Phoenix ICON, 100° FOV · infant wide-field fundus photograph · 1240 by 1240 pixels.
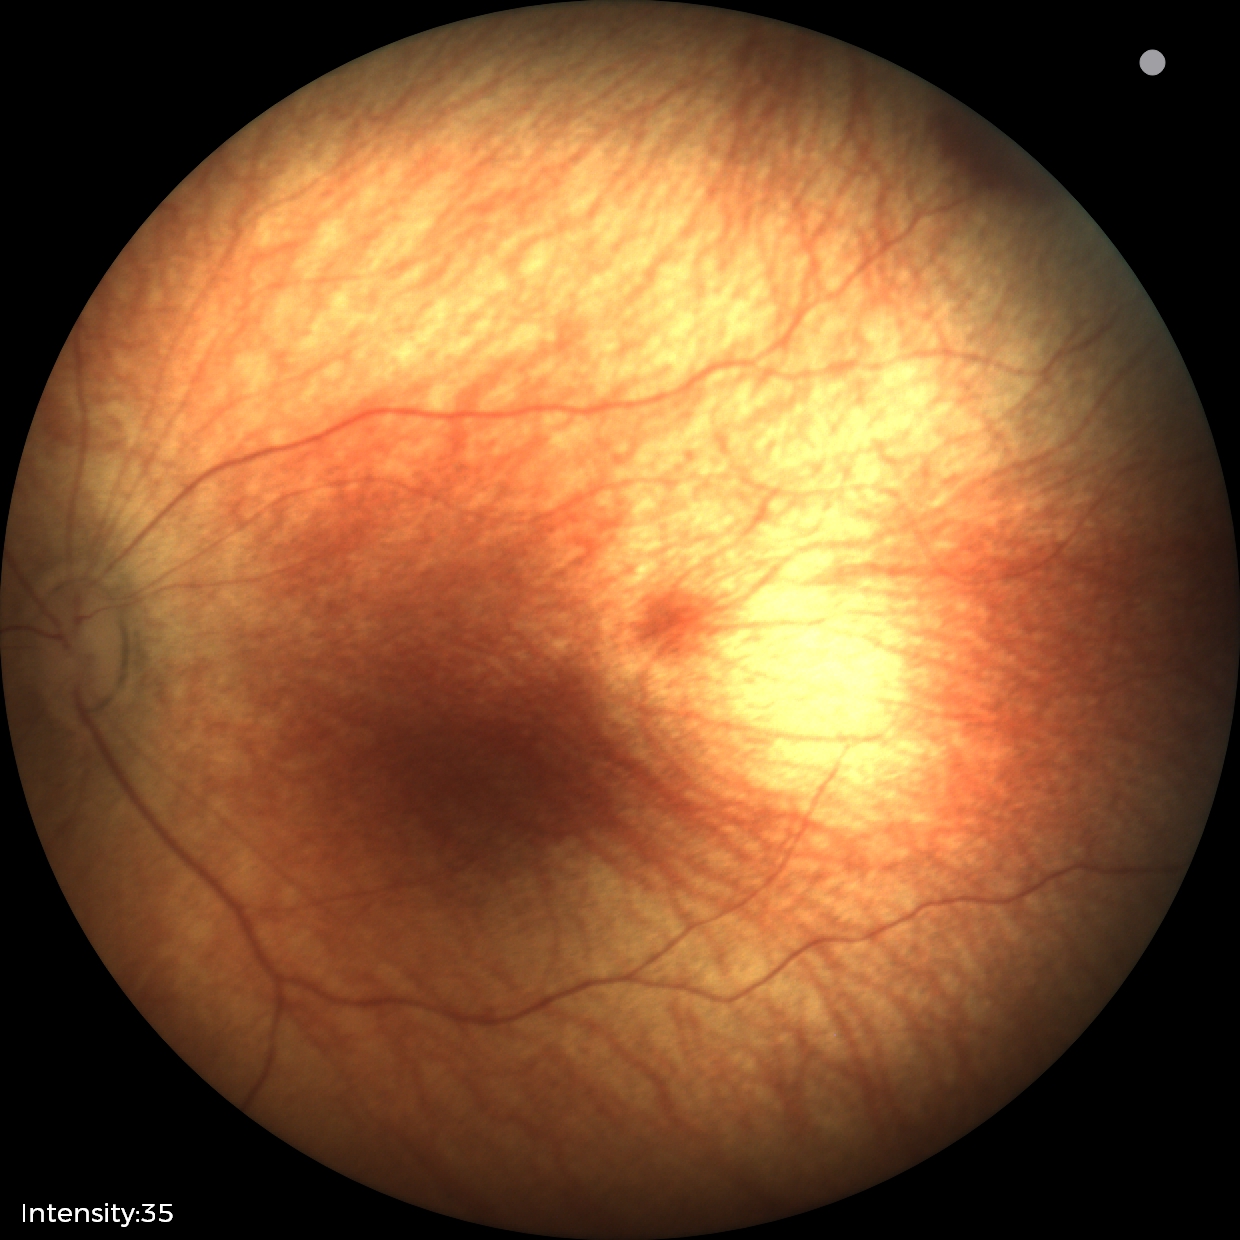

Diagnosis from this screening exam: retinal hemorrhages.